Color fundus image · acquired with a NIDEK AFC-230:
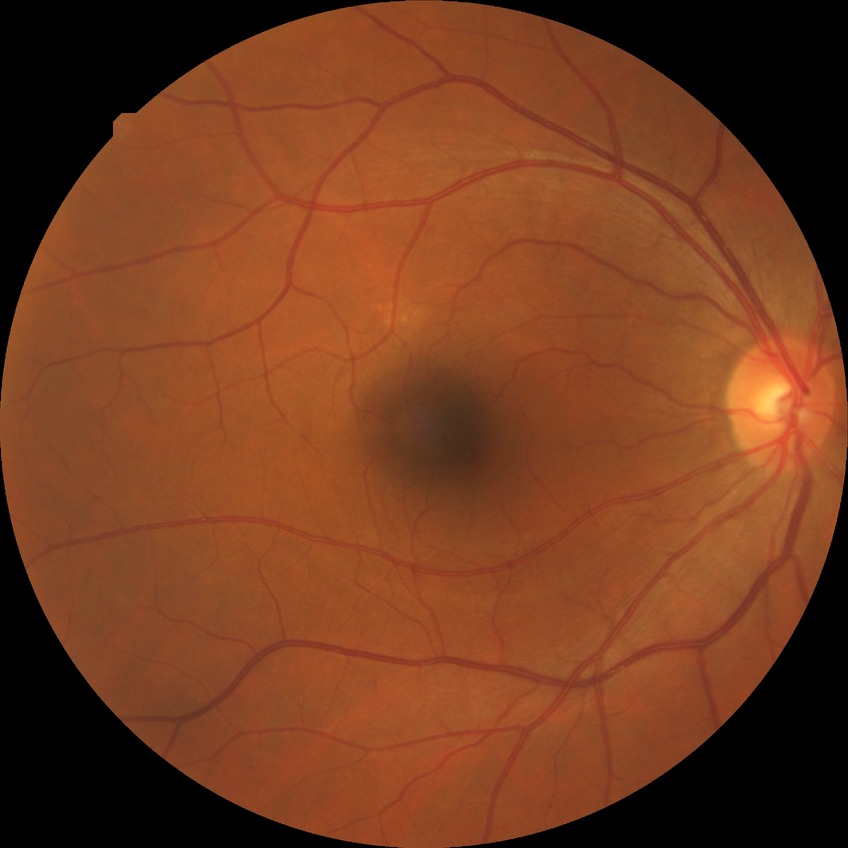

modified Davis grading: simple diabetic retinopathy.